2212x1659; fundus photo taken with a portable handheld camera:
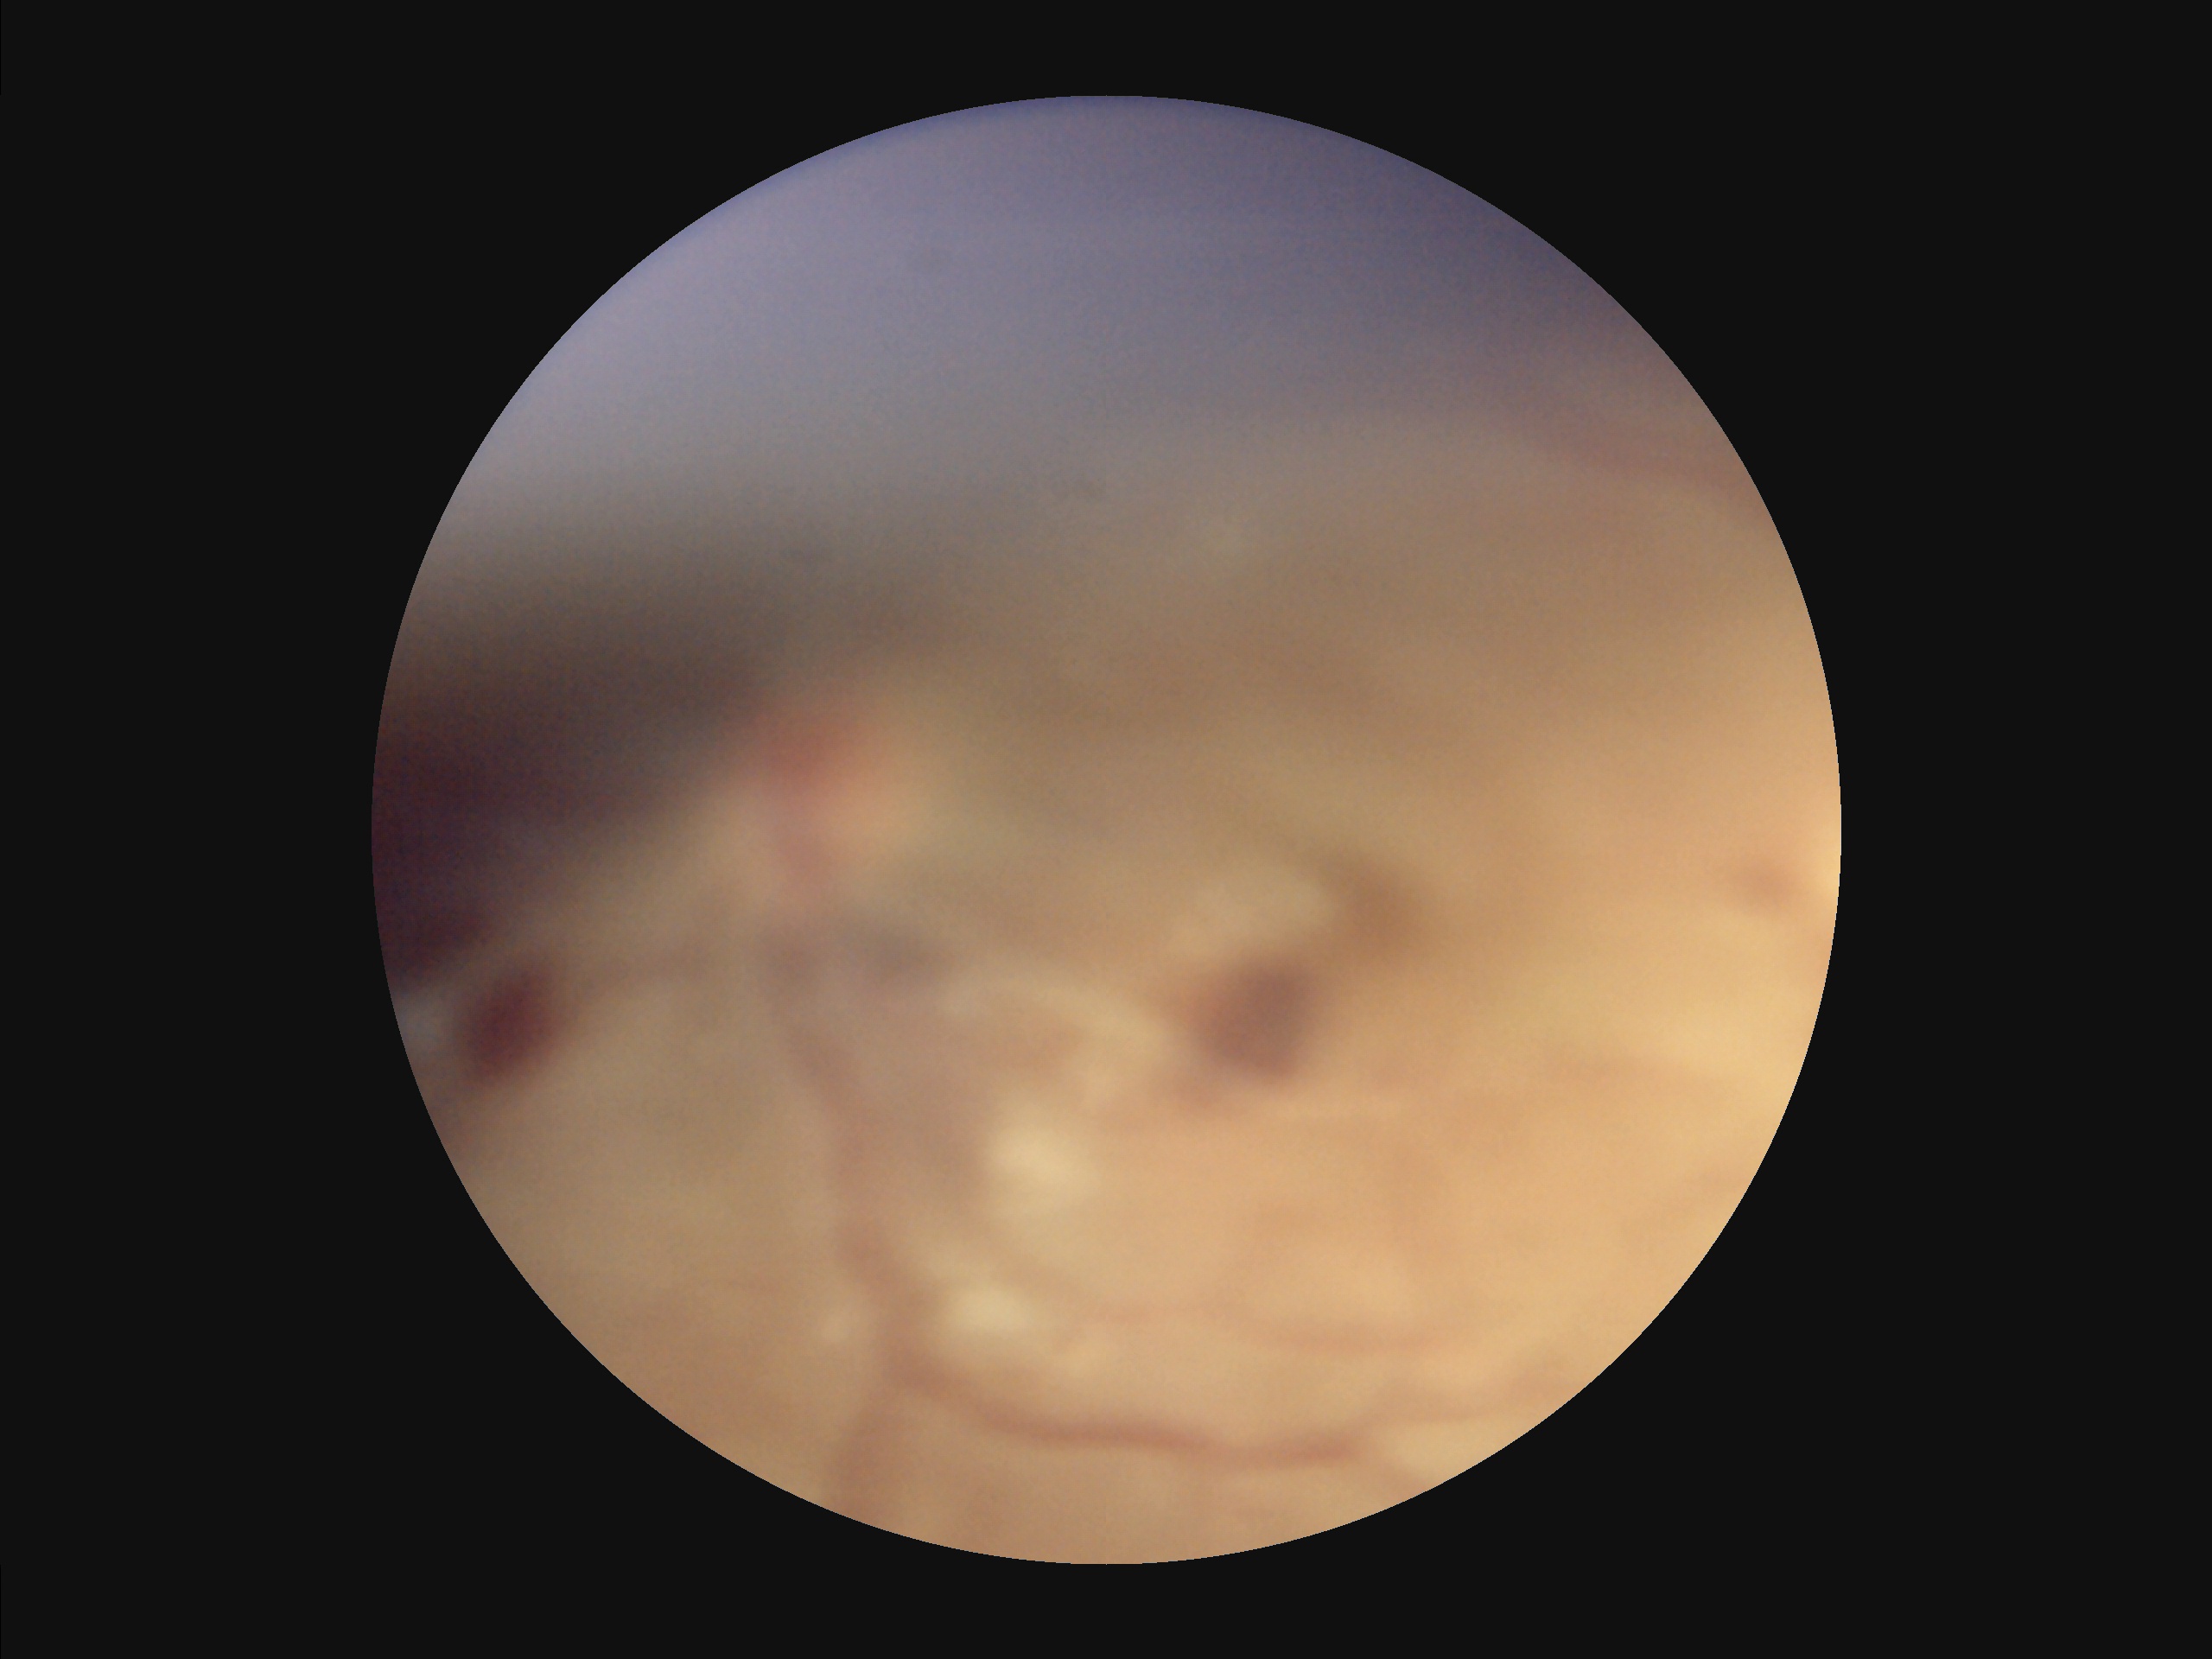 Out of focus; structures are indistinct.
Overall quality is poor; the image is difficult to grade.
Illumination is uneven.
Vessels and details are hard to distinguish.